2048x1536px. CFP: 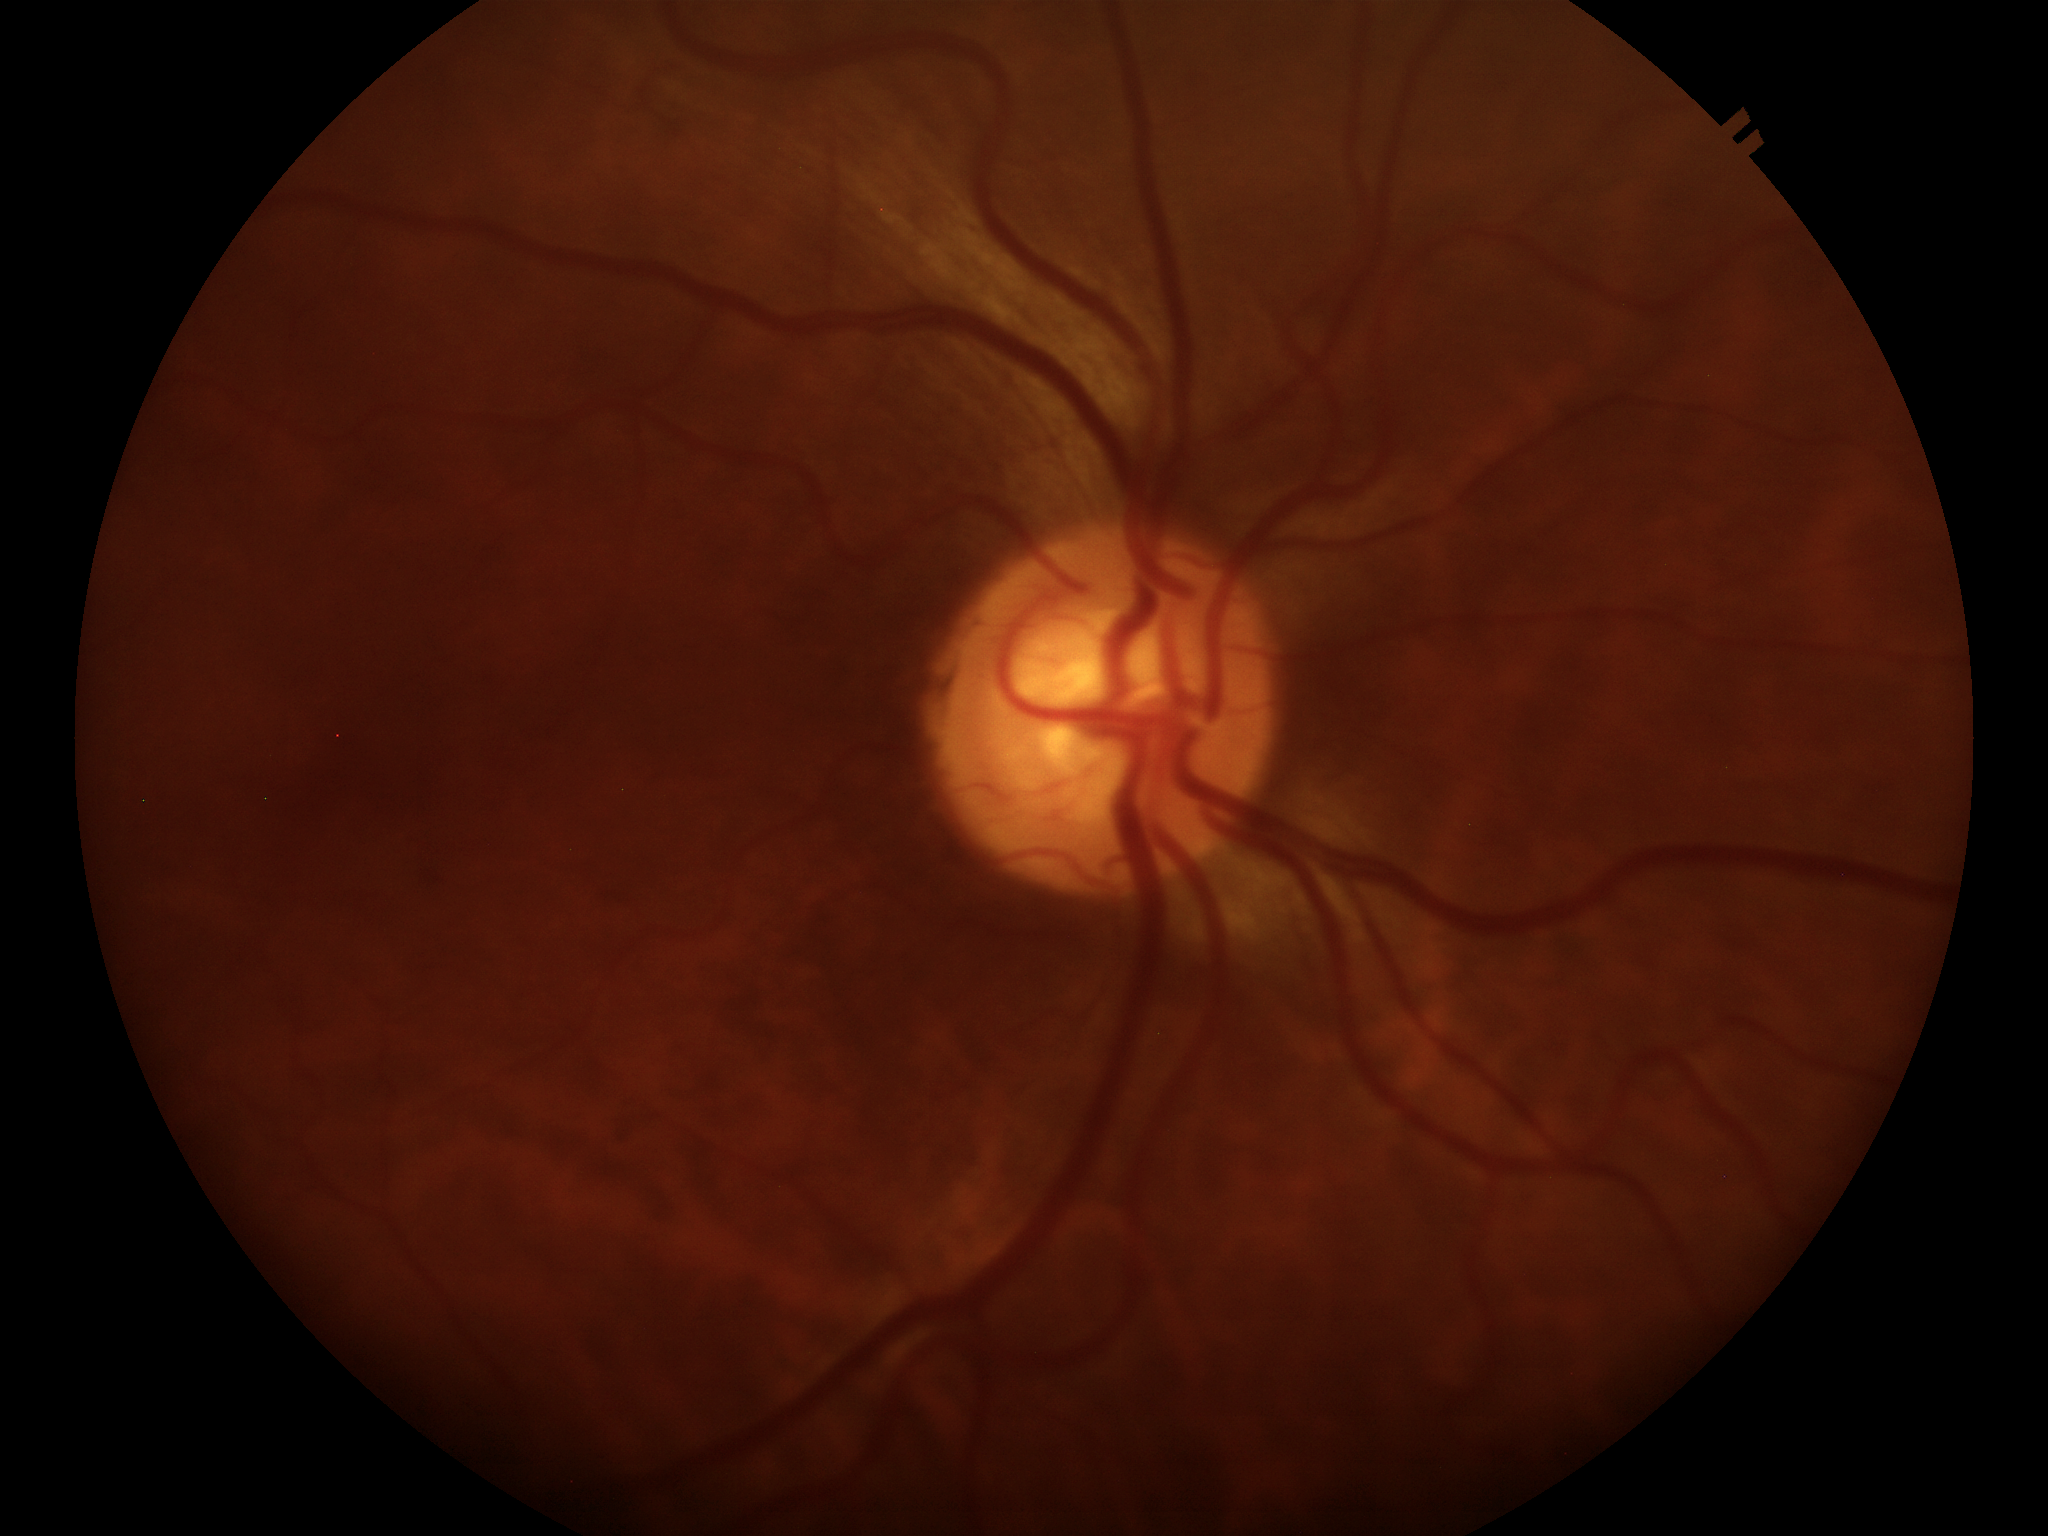
Vertical cup-to-disc ratio is 0.57. Horizontal CDR of 0.56. Glaucoma assessment: not suspect (2/5 graders called glaucoma suspect).